ONH-centered crop from a color fundus image — 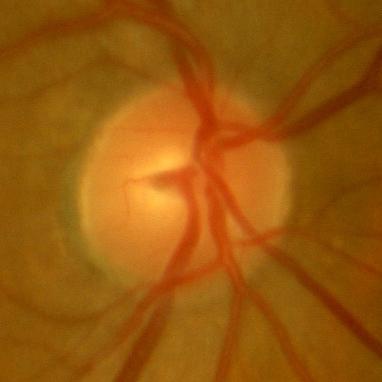

Findings consistent with no evidence of glaucoma.